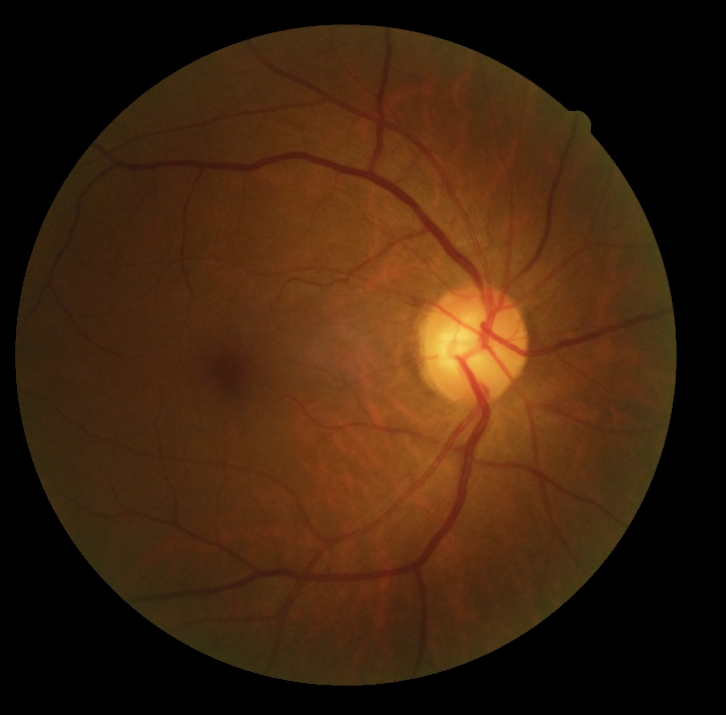 No DR findings. DR: no apparent retinopathy (grade 0) — no visible signs of diabetic retinopathy.